Acquired on the Natus RetCam Envision · wide-field fundus photograph from neonatal ROP screening
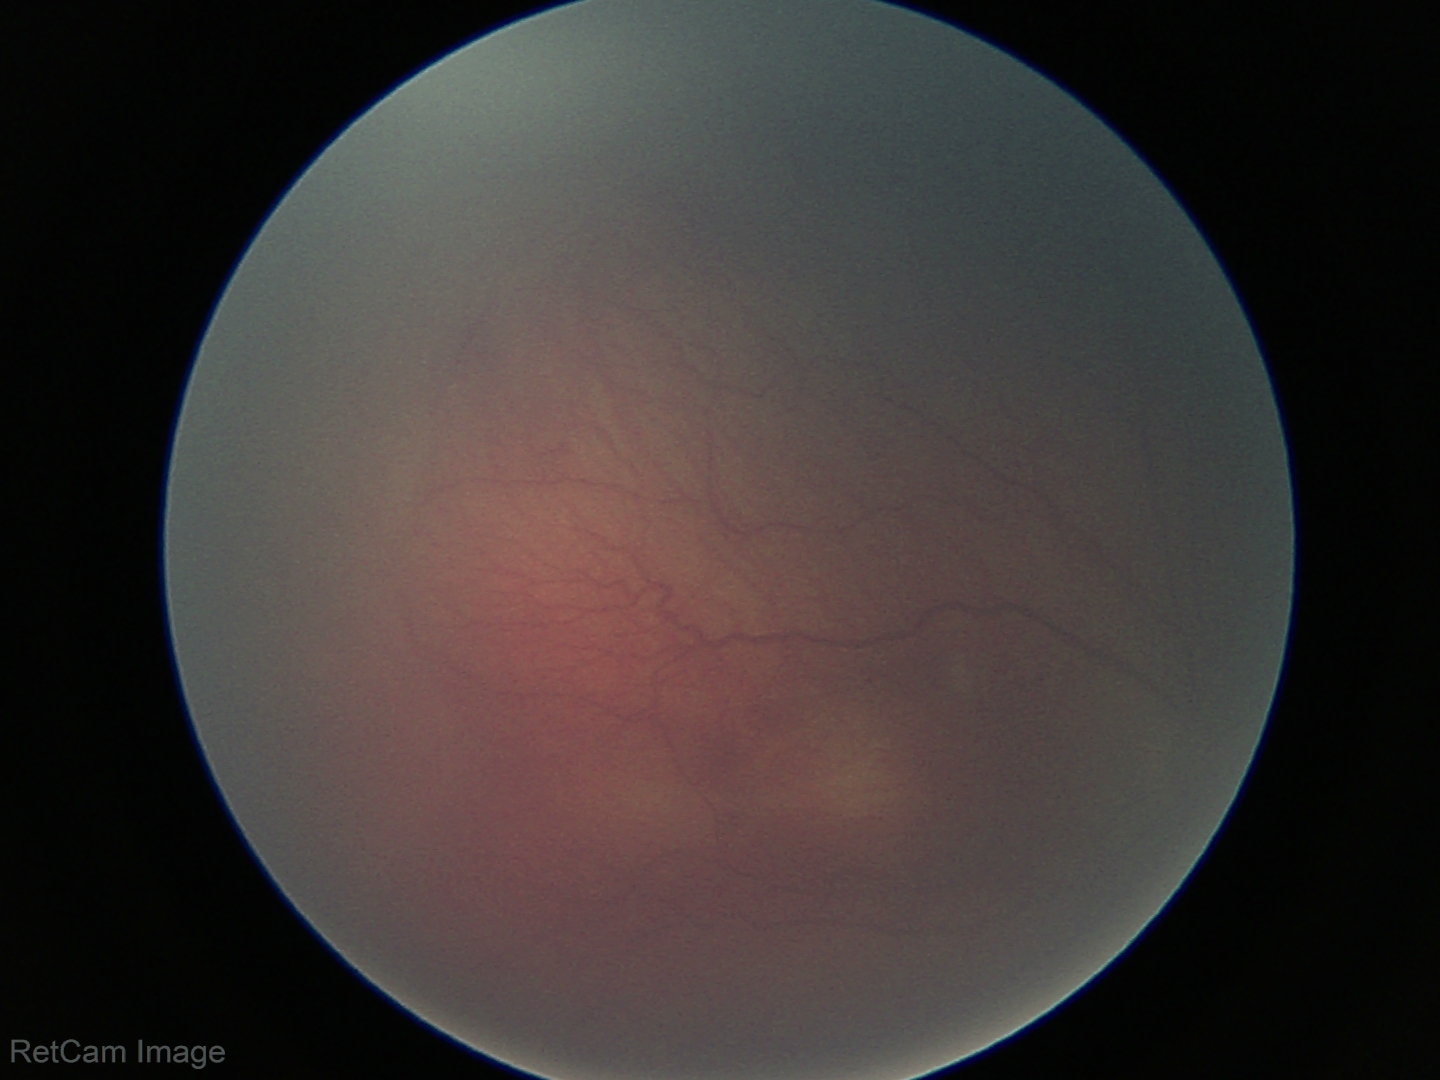
Screening: no plus disease — posterior pole vessels without abnormal dilation or tortuosity | retinopathy of prematurity stage 2.